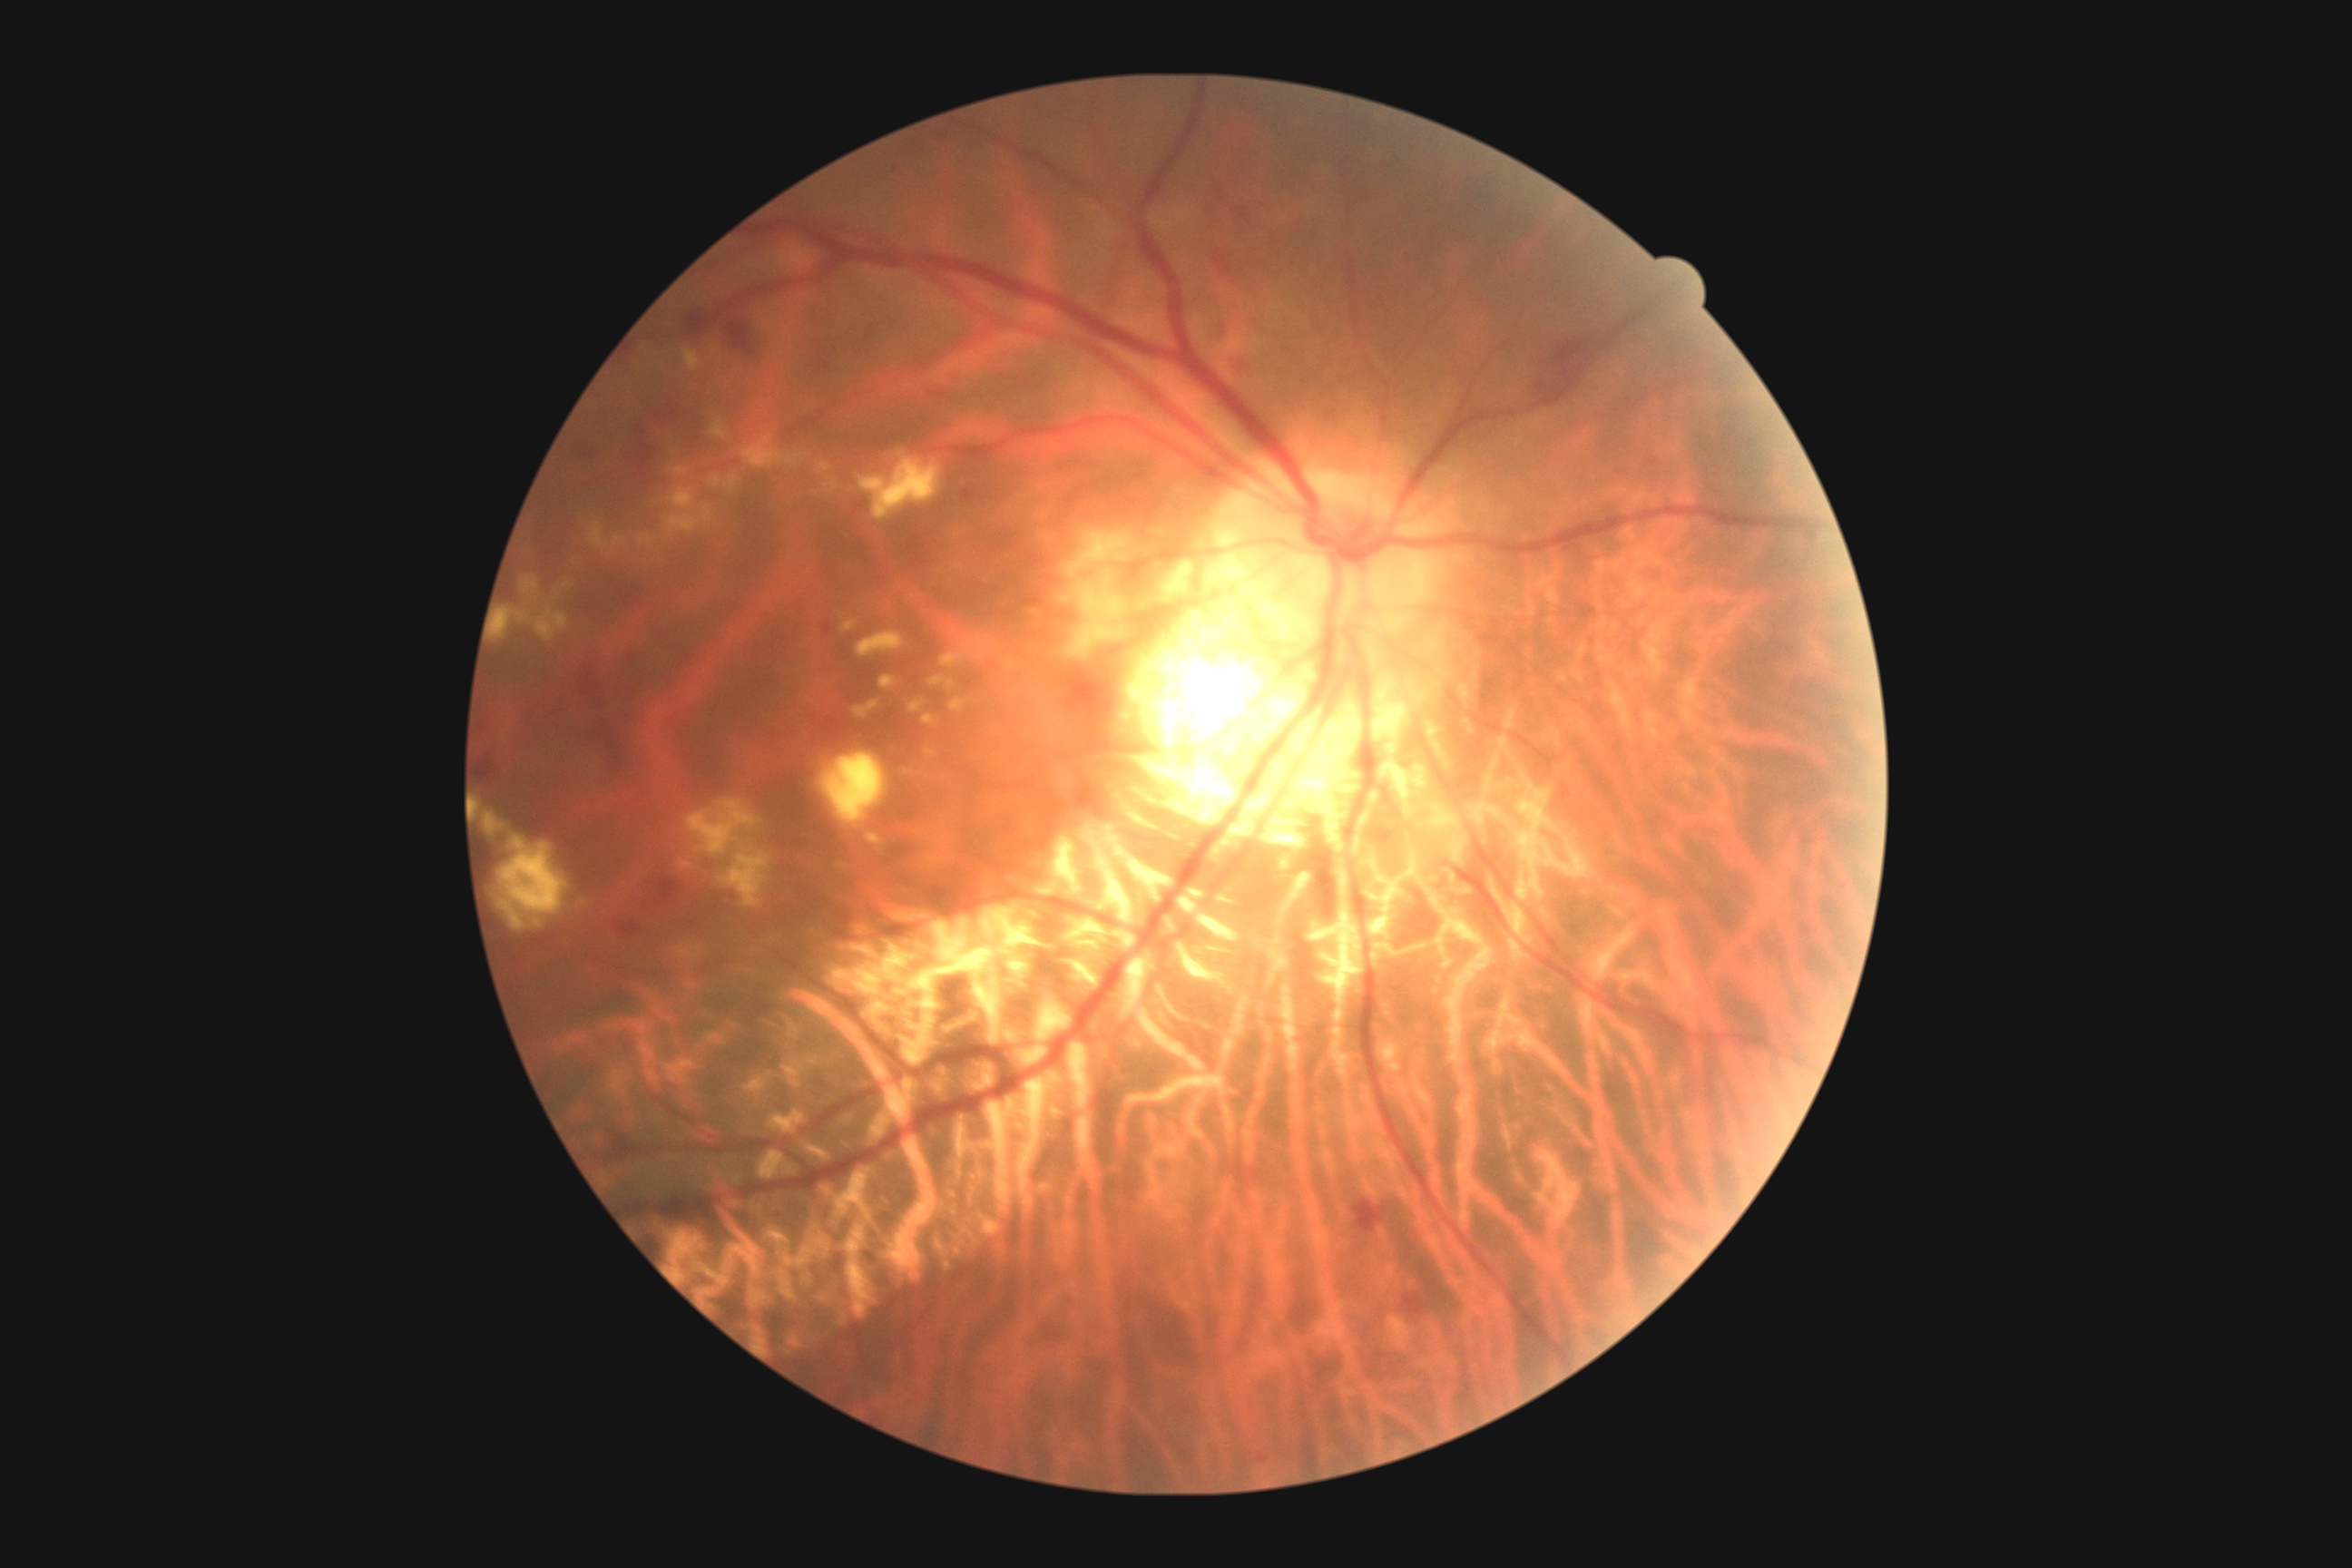
DR severity: moderate non-proliferative diabetic retinopathy (grade 2).